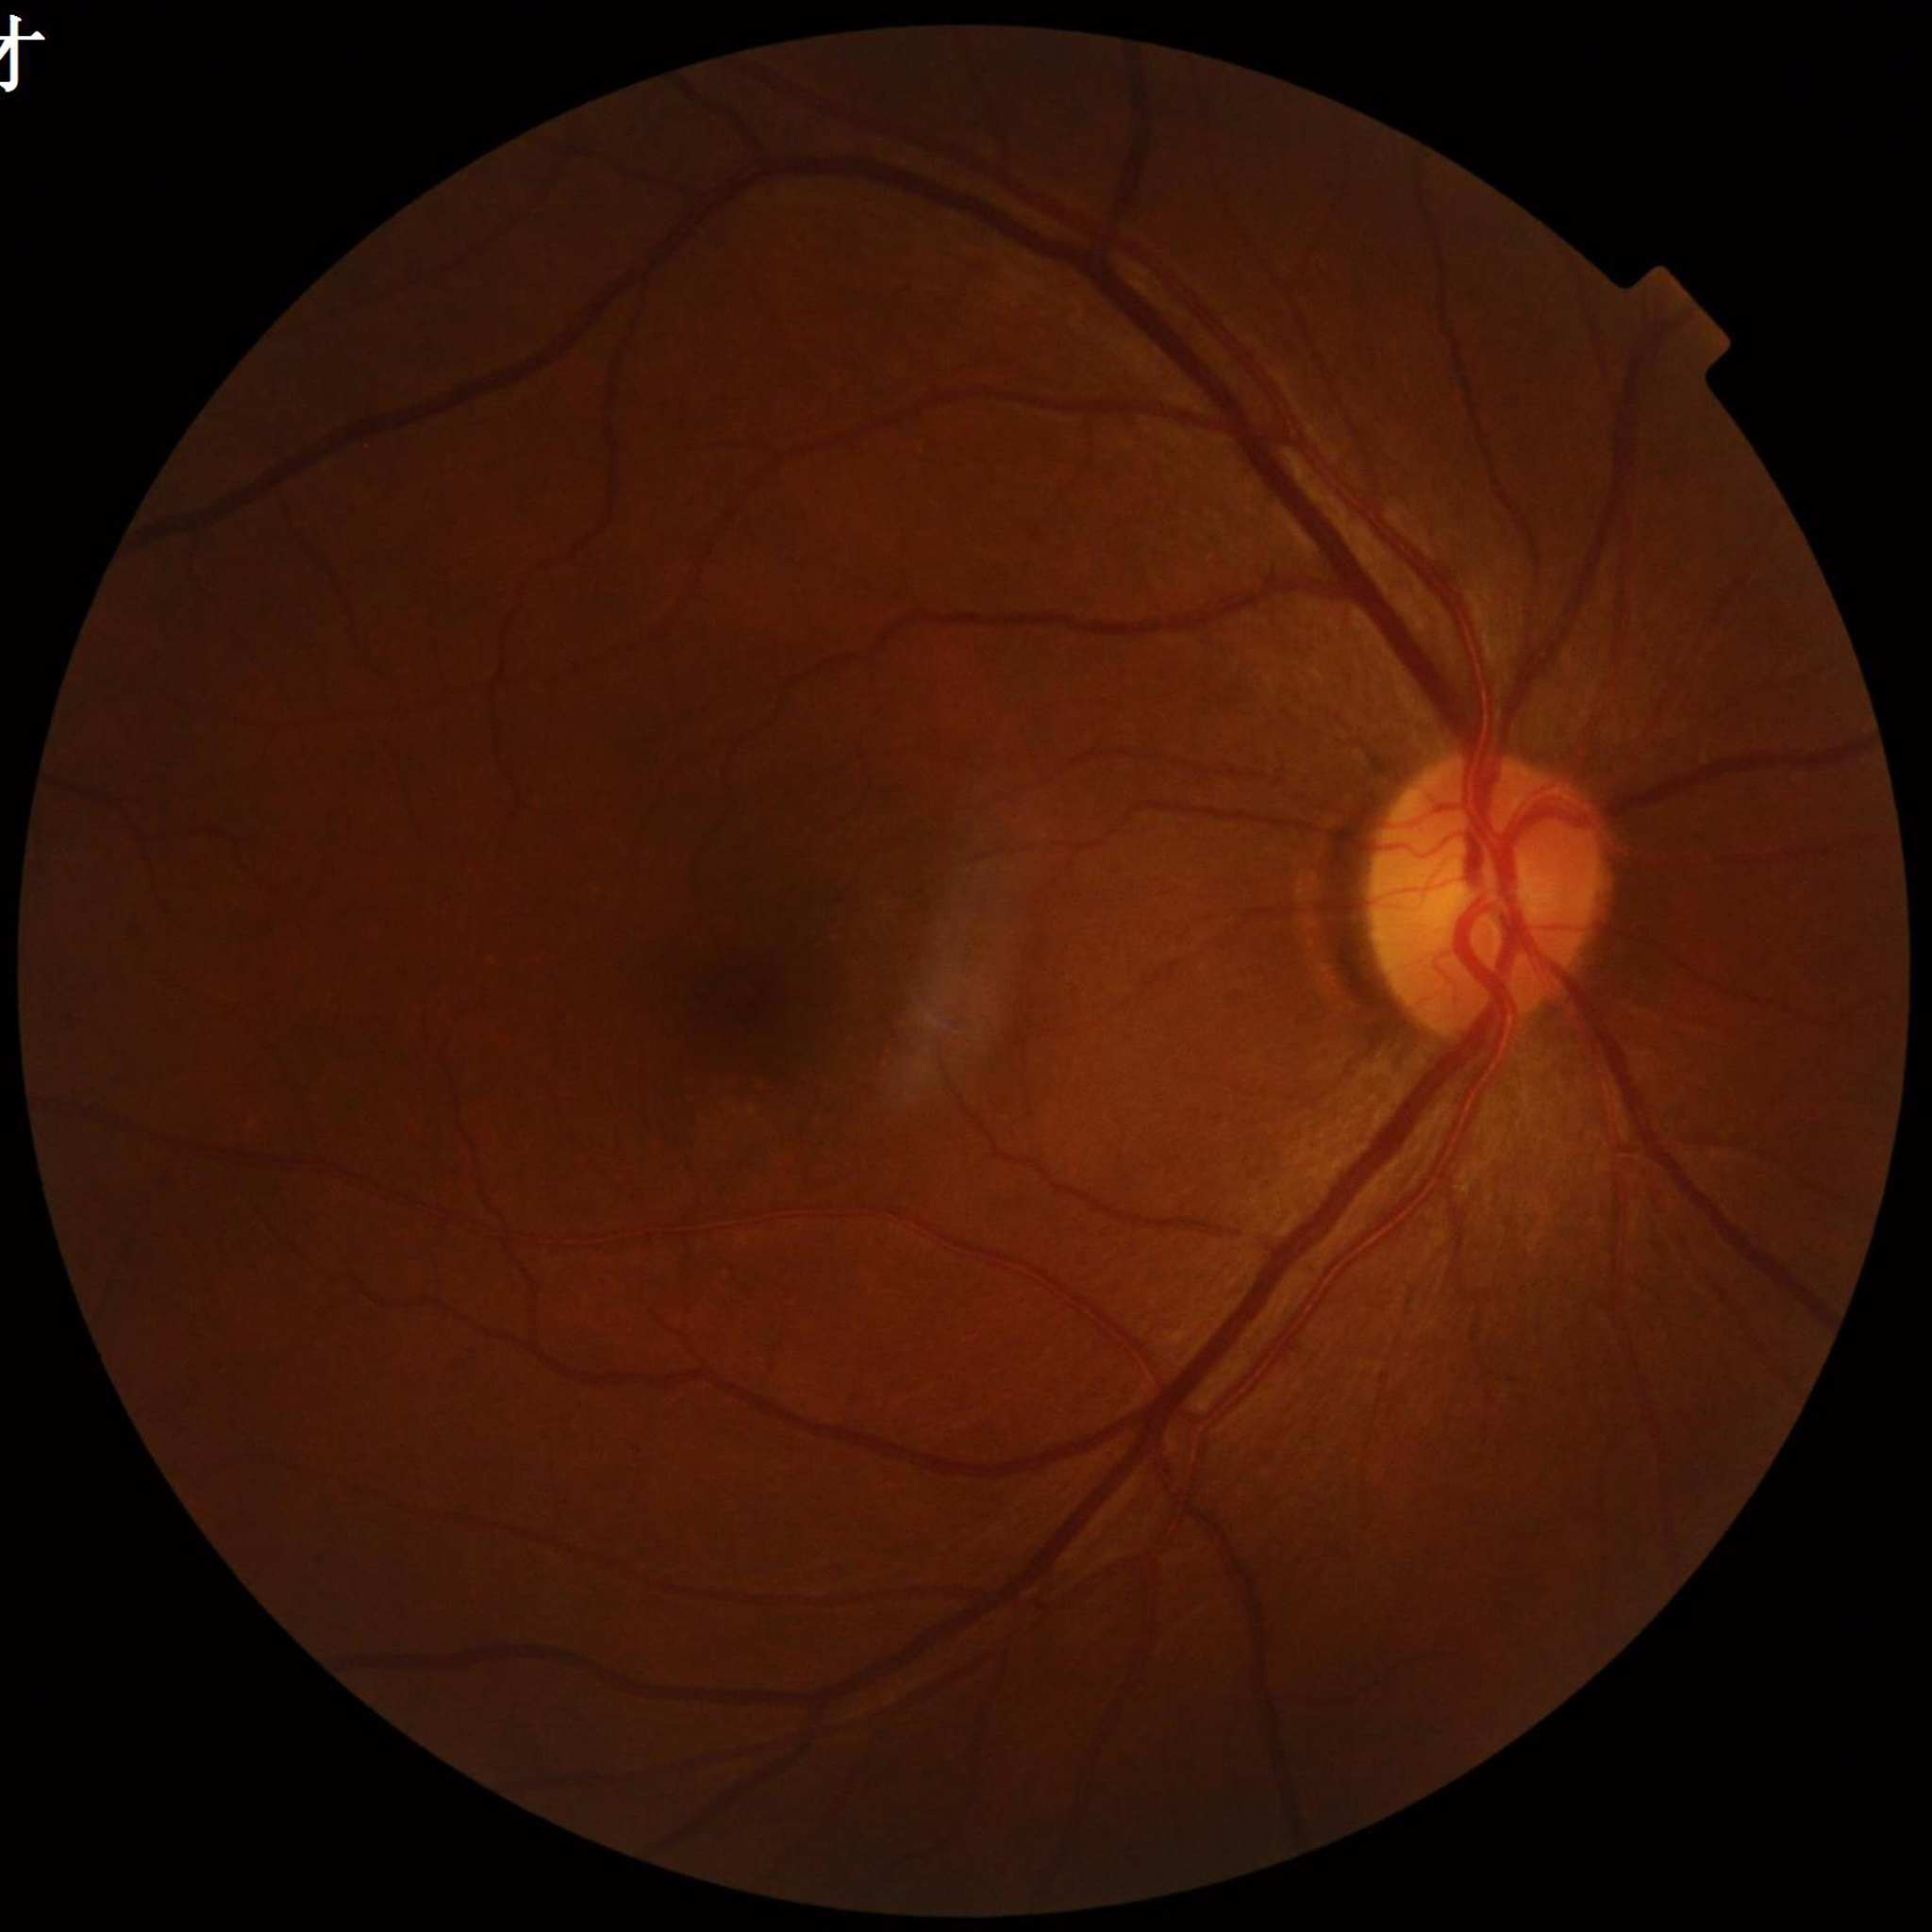 Clinical diagnosis: diabetic retinopathy